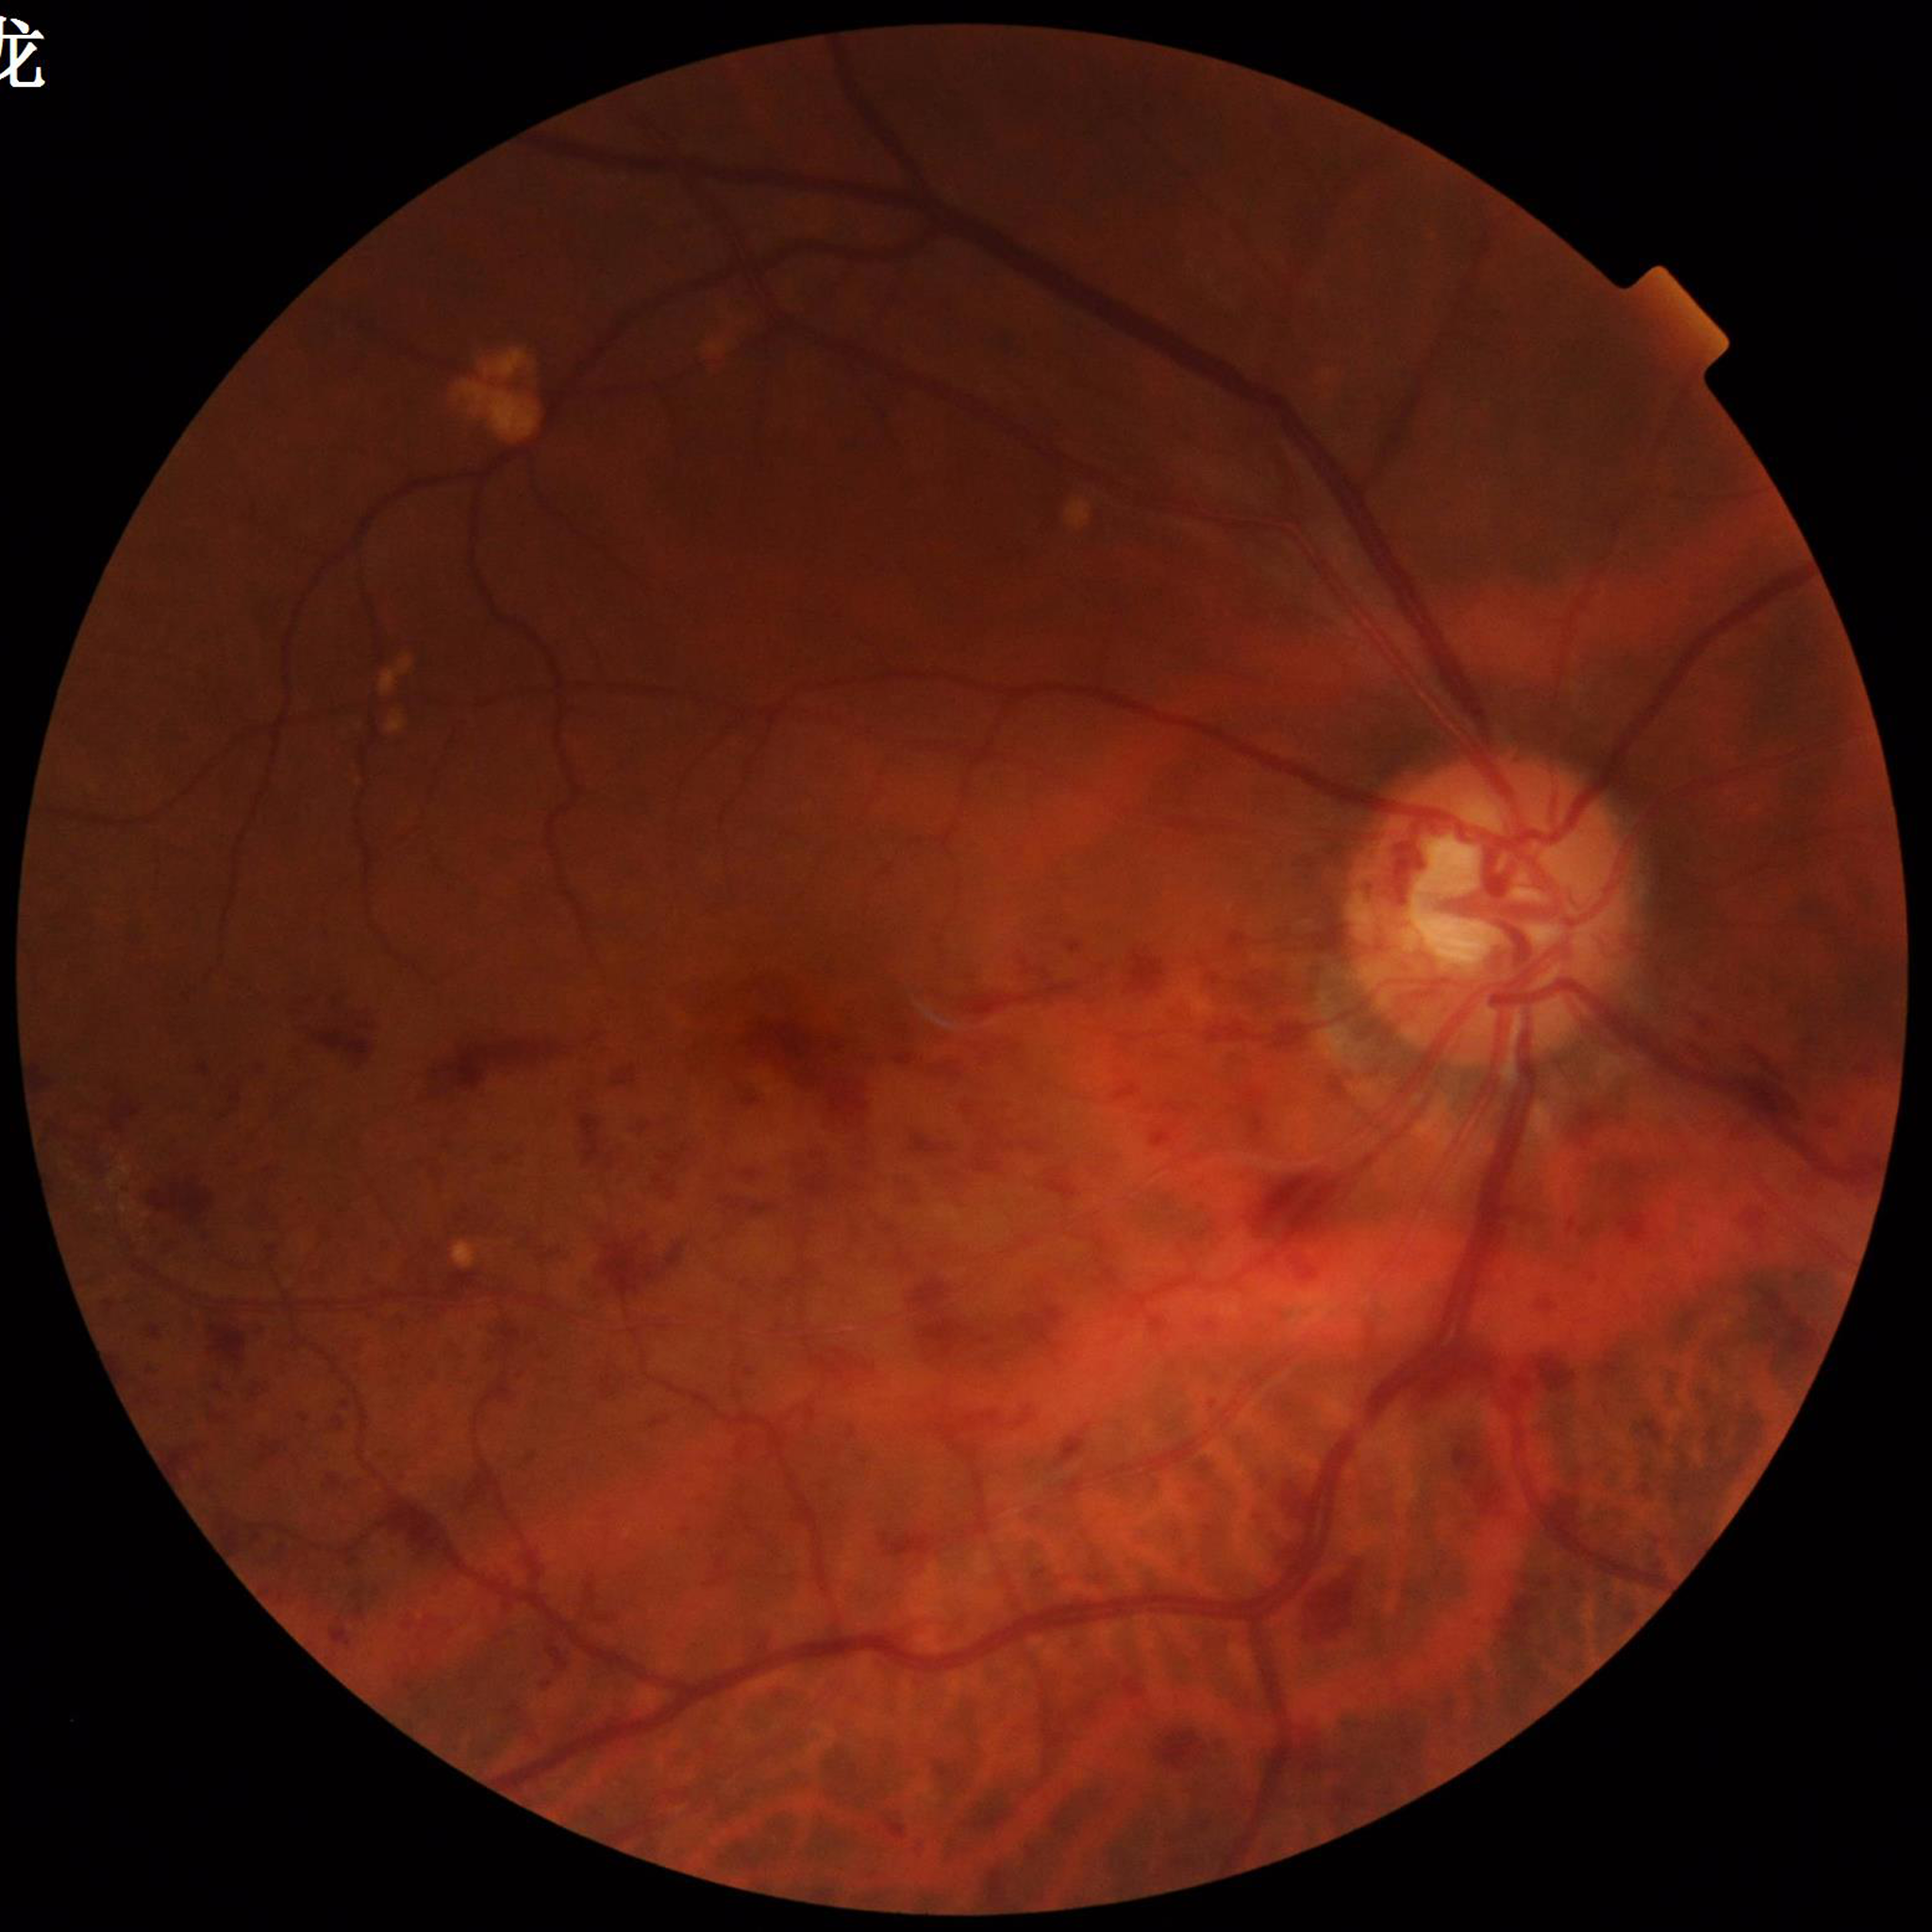 Condition: AMD